Nonmydriatic fundus photograph; modified Davis grading.
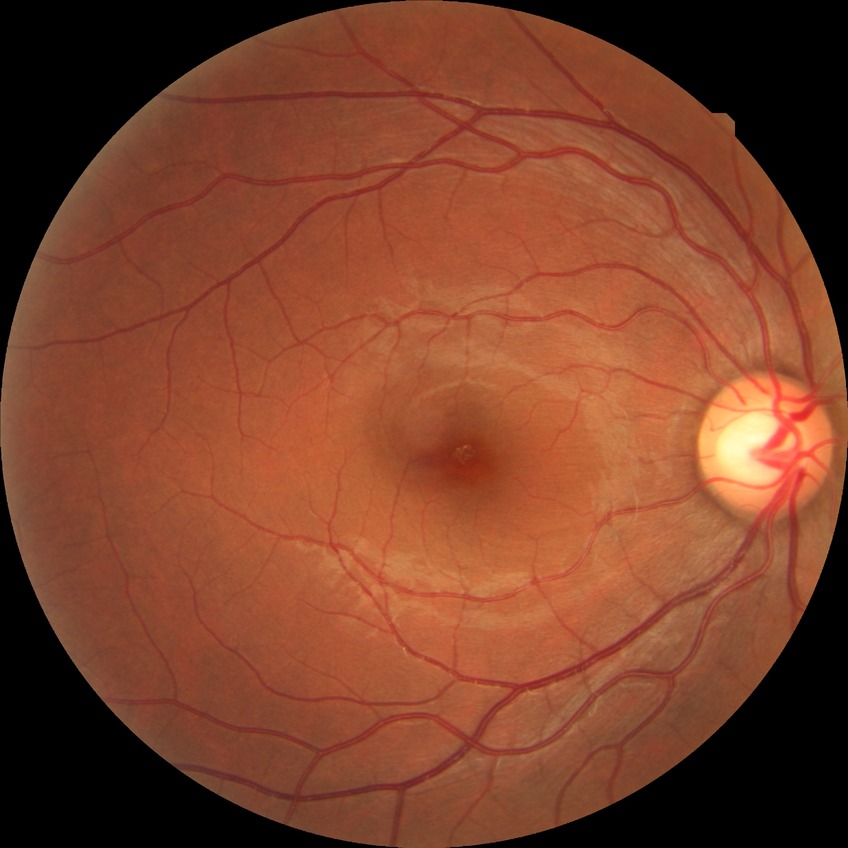

Diabetic retinopathy (DR): NDR (no diabetic retinopathy).